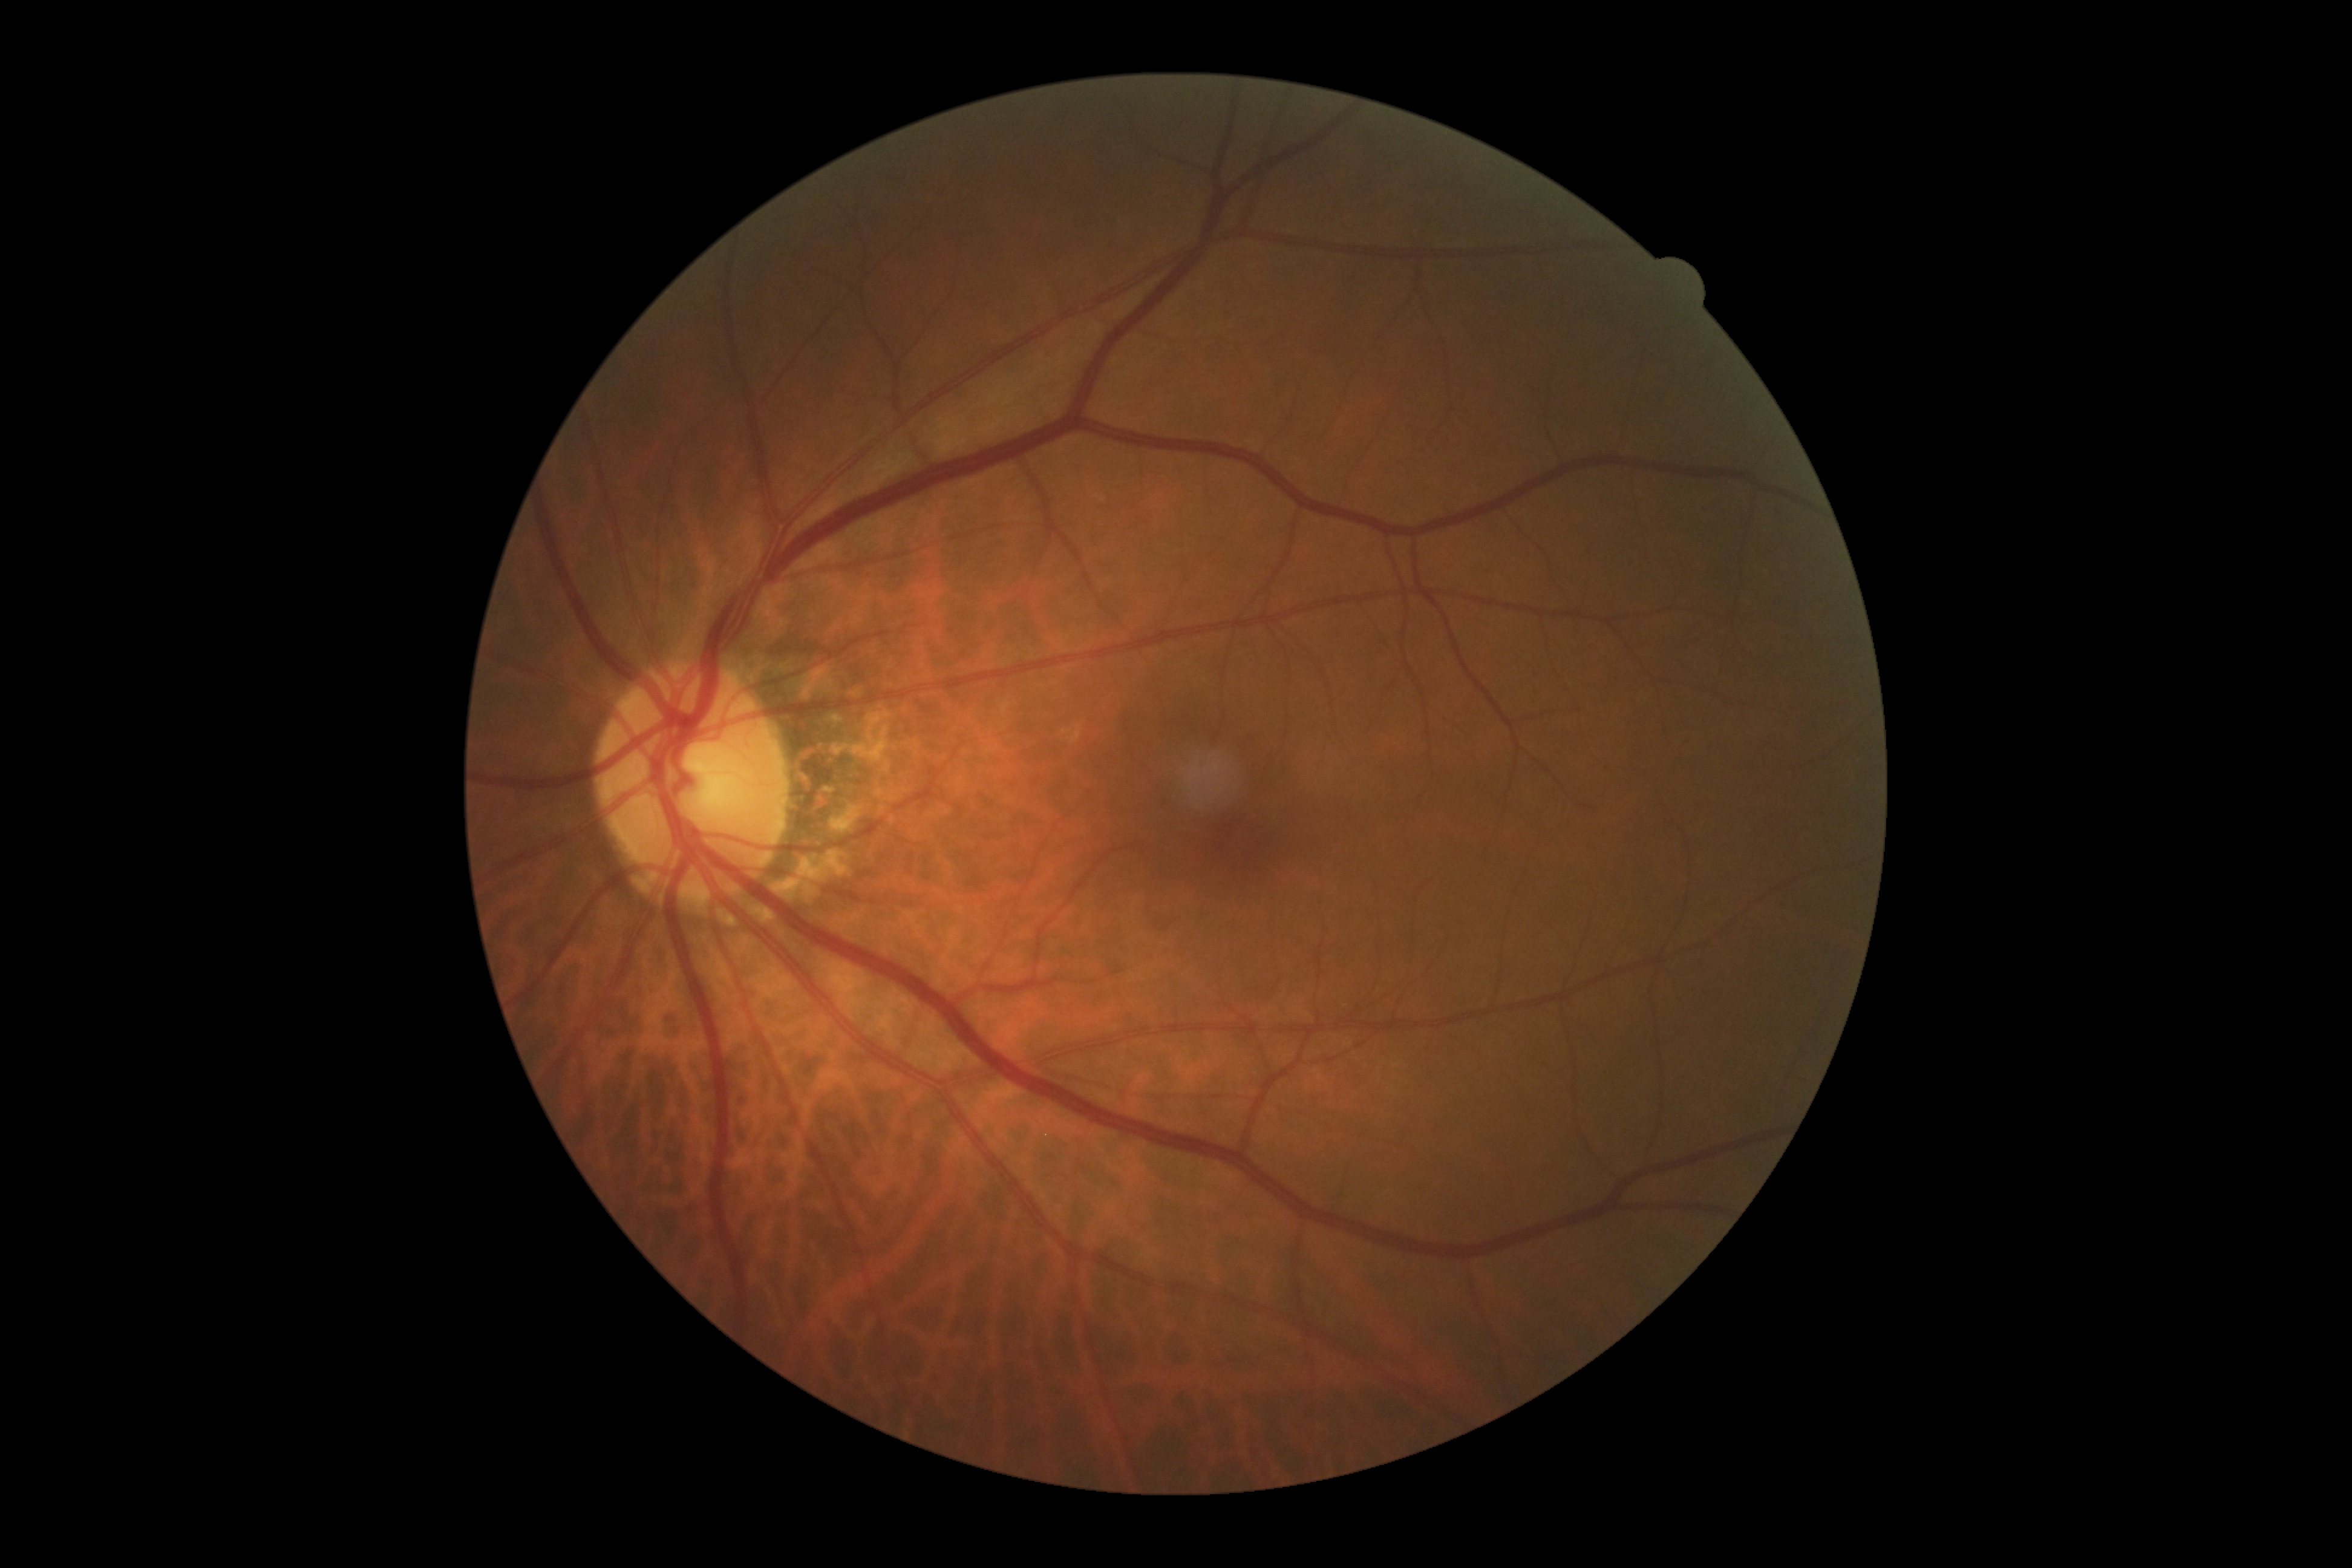 Diabetic retinopathy (DR): no apparent retinopathy (grade 0).